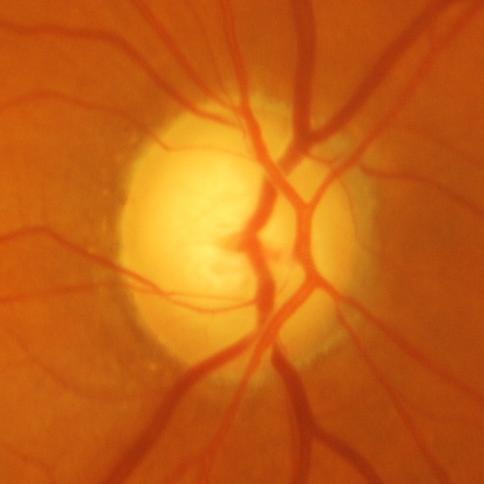
Q: Is there glaucomatous optic neuropathy?
A: Yes — glaucomatous optic neuropathy.